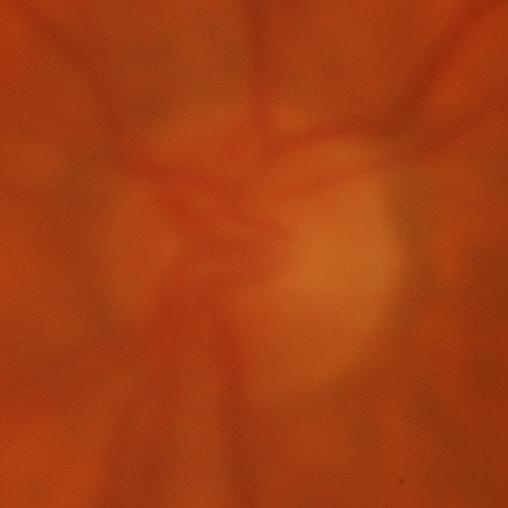

Evidence of glaucoma.